1240x1240px · infant wide-field fundus photograph · camera: Phoenix ICON (100° FOV):
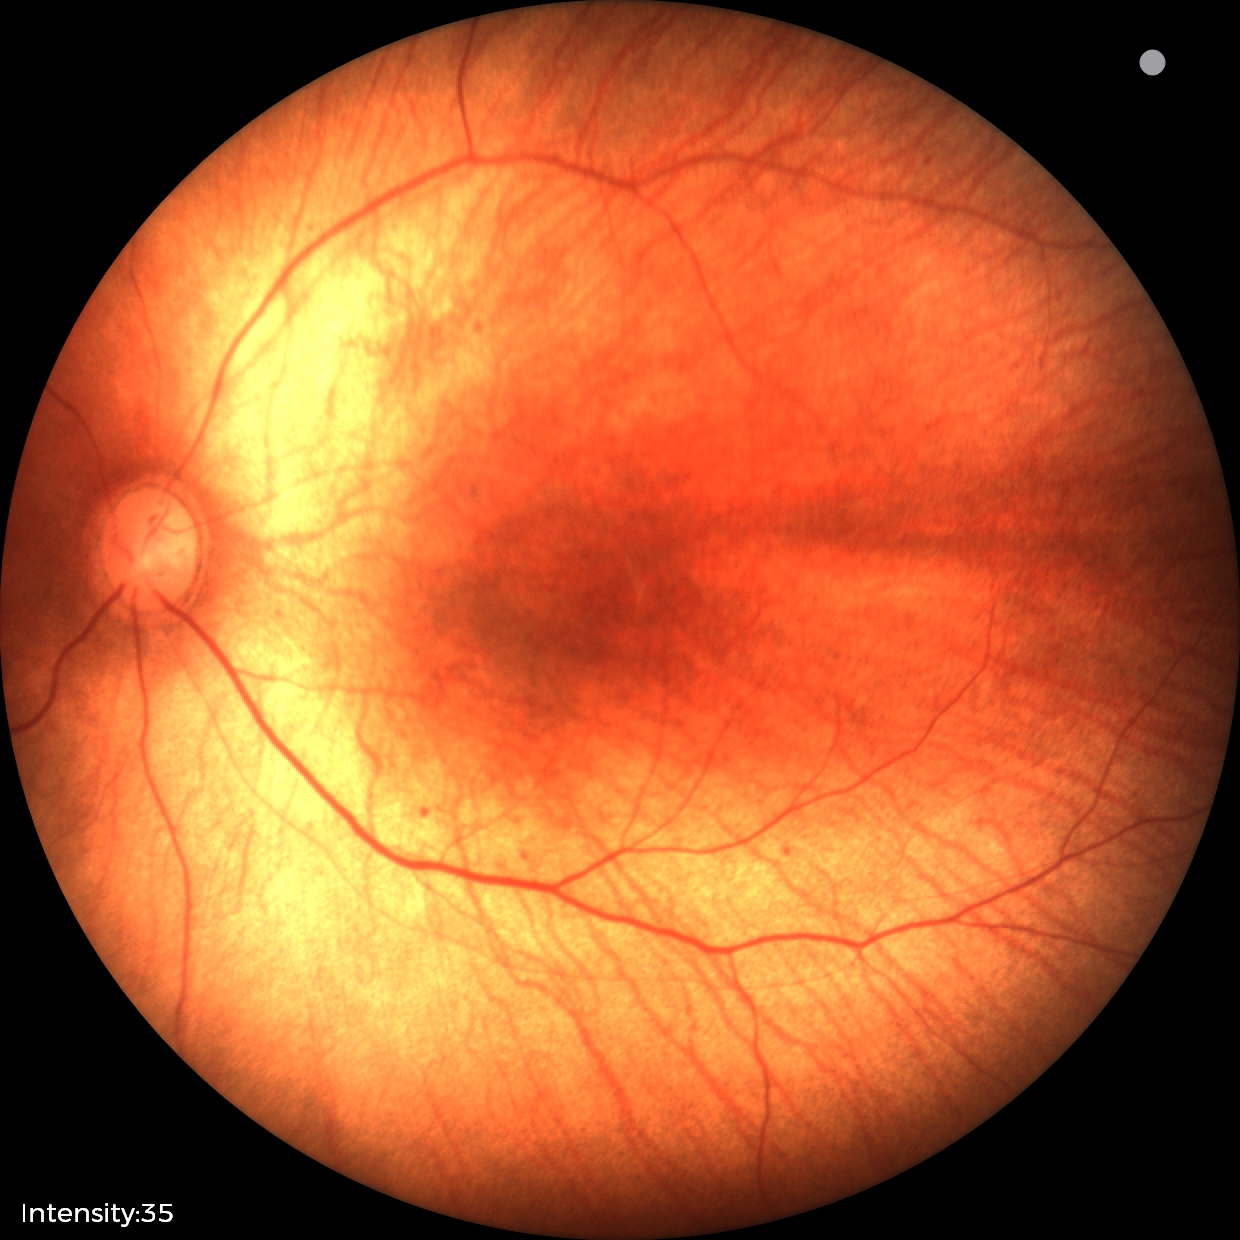

No retinal pathology identified on screening.